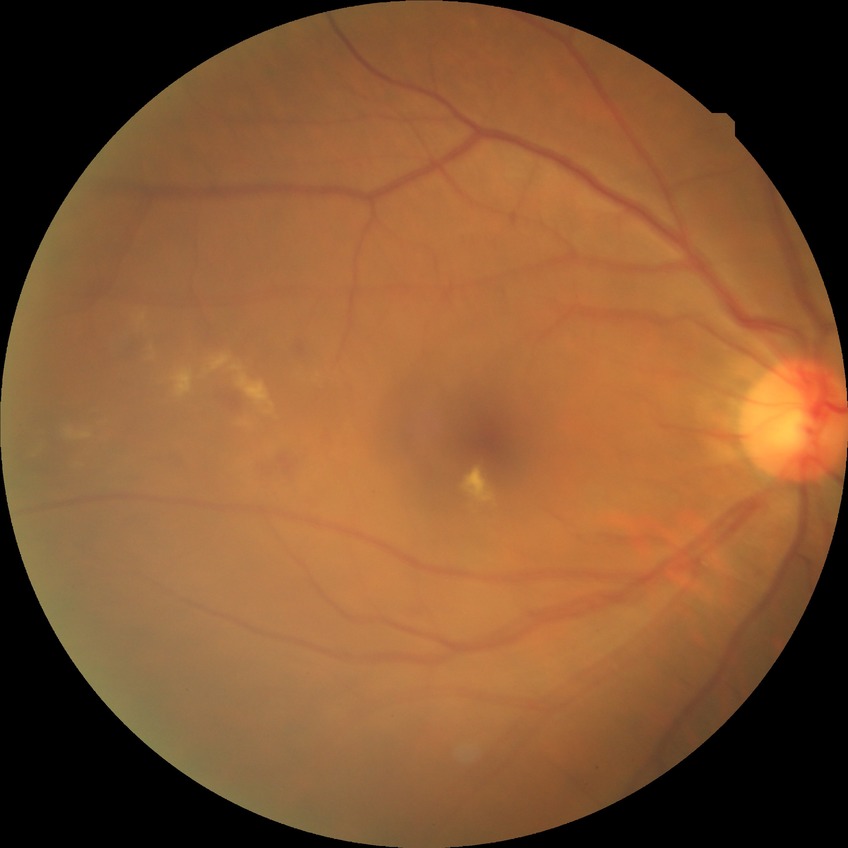 Diabetic retinopathy (DR): simple diabetic retinopathy (SDR).